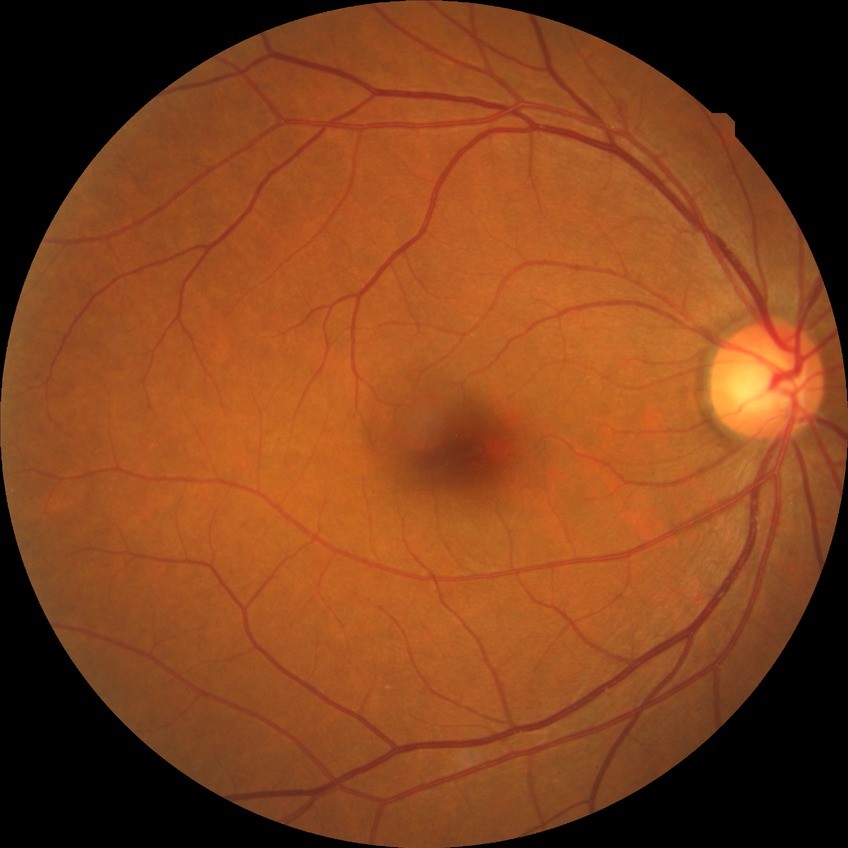   davis_grade: simple diabetic retinopathy